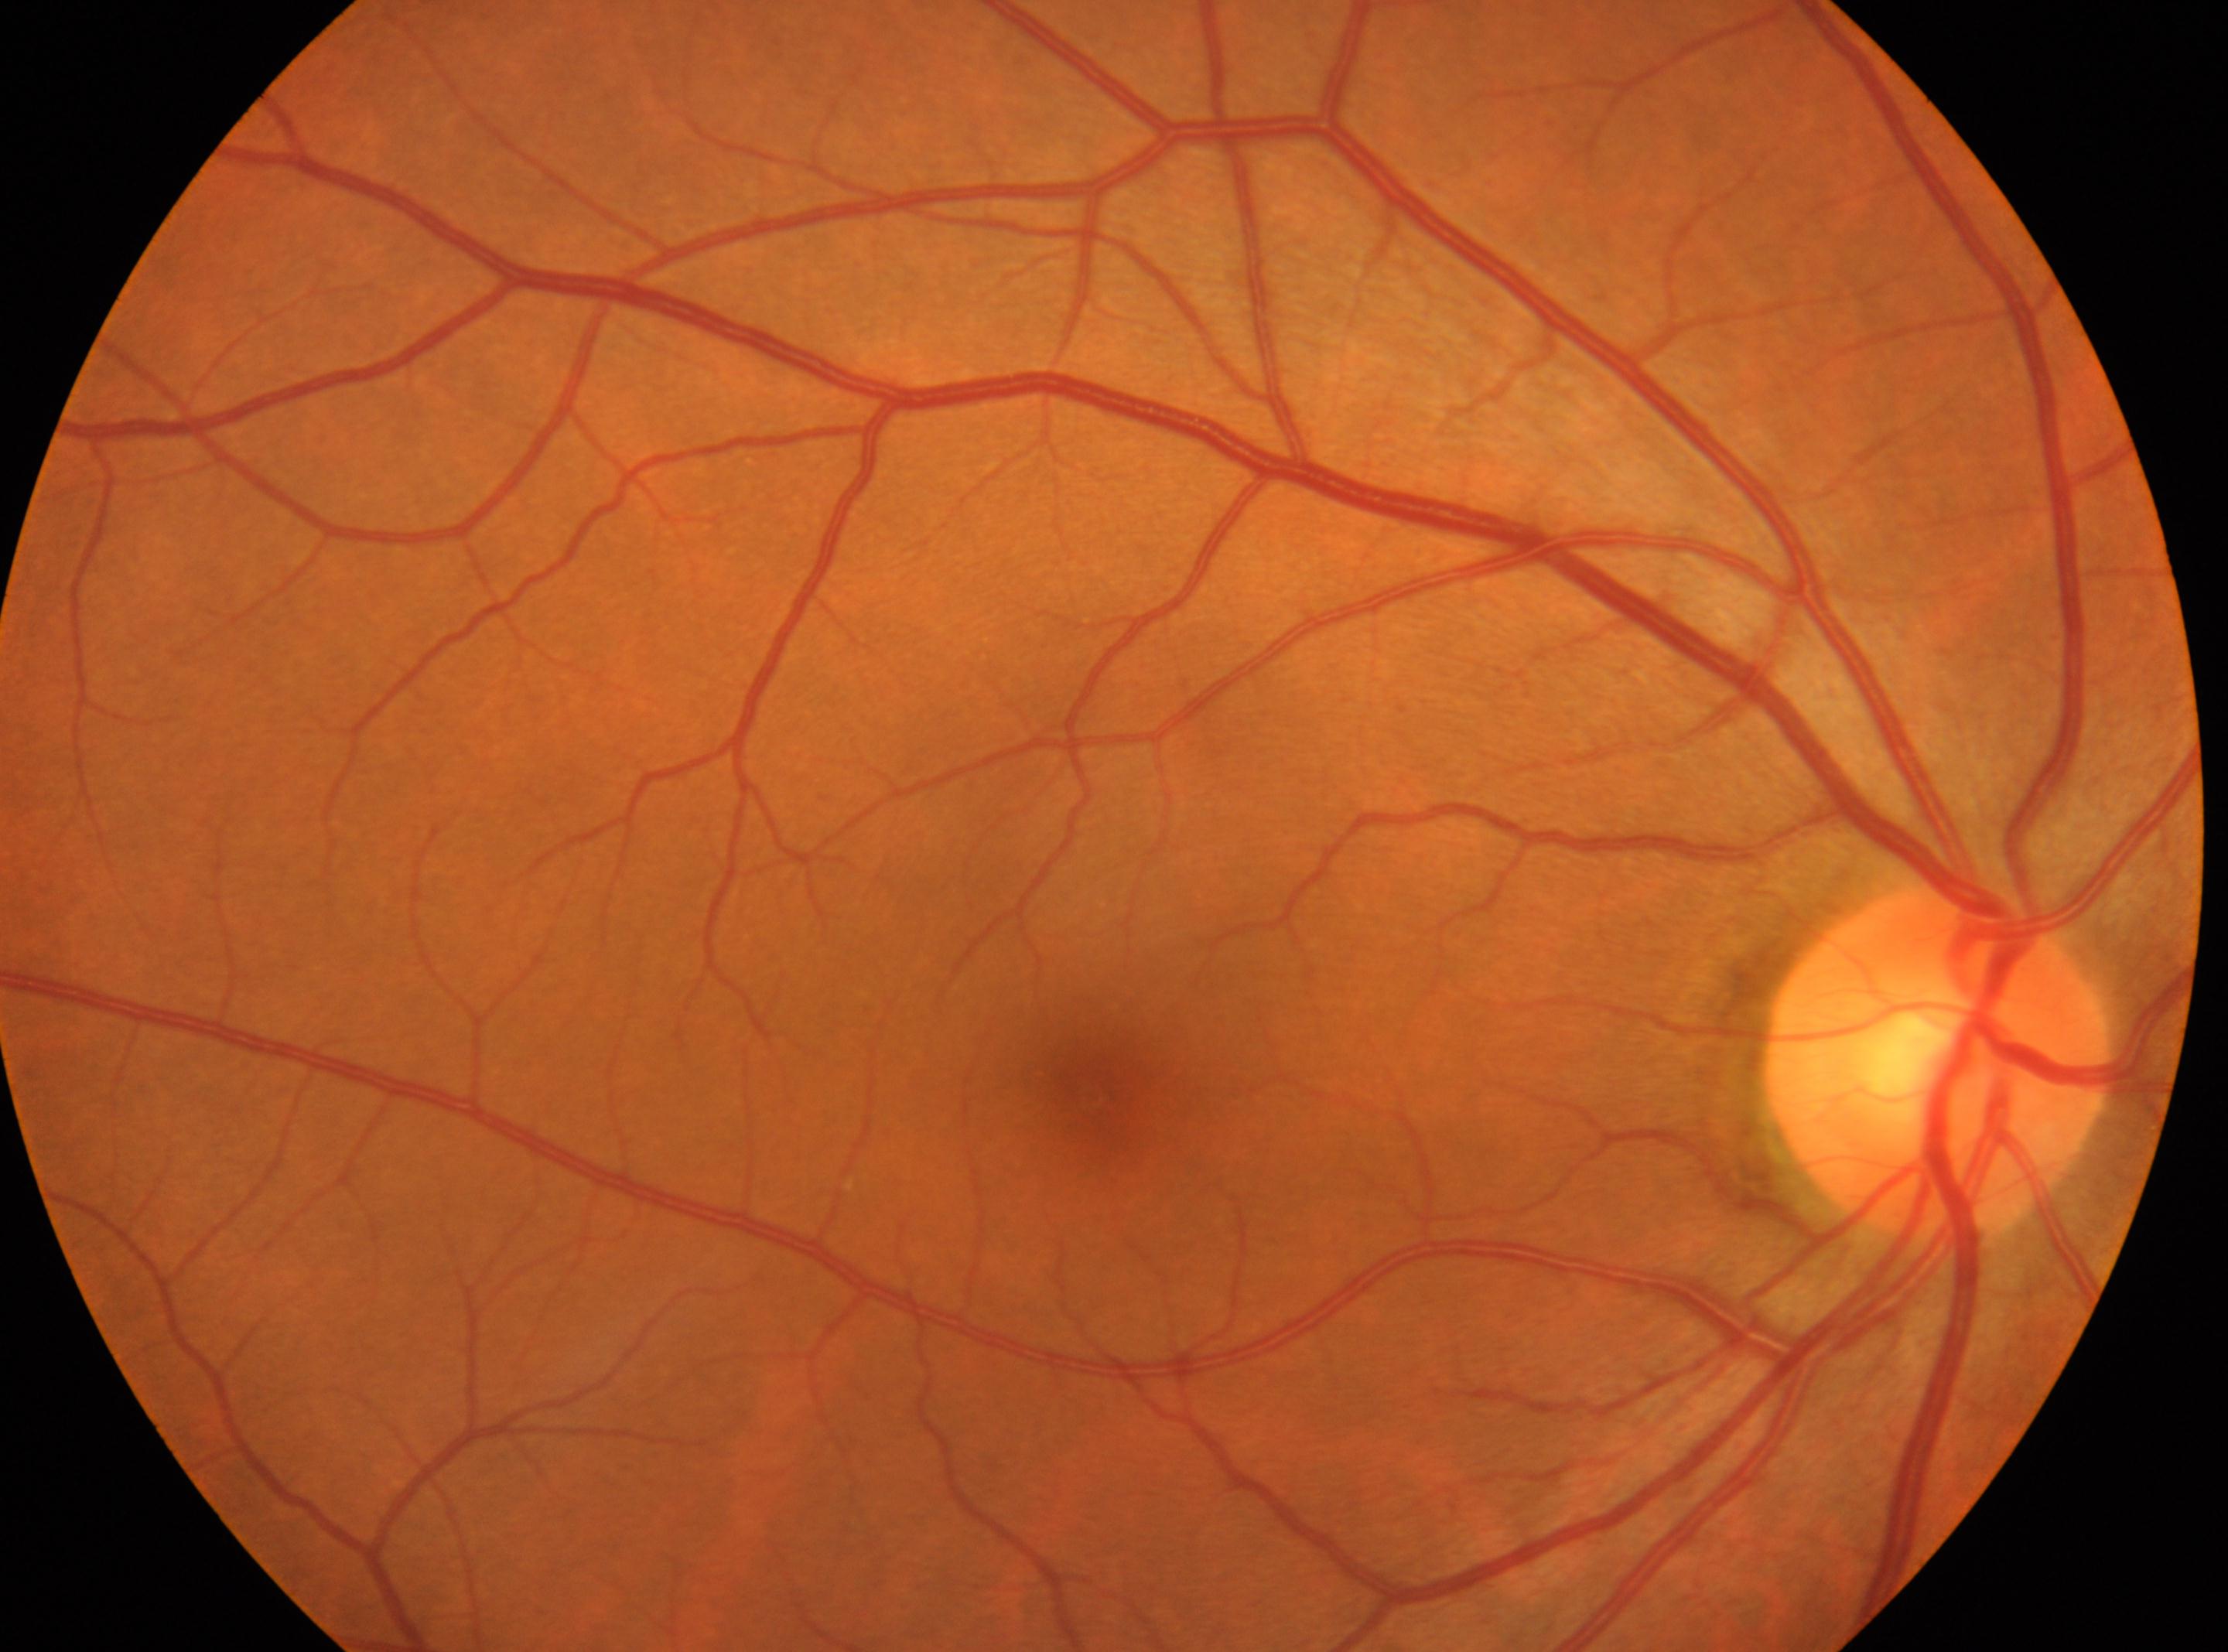
Optic disk: (1937, 1060).
Fovea: (1095, 1086).
Imaged eye: oculus dexter.
No apparent diabetic retinopathy.
DR: no apparent retinopathy (grade 0).